Color fundus image, 45° FOV, Davis DR grading:
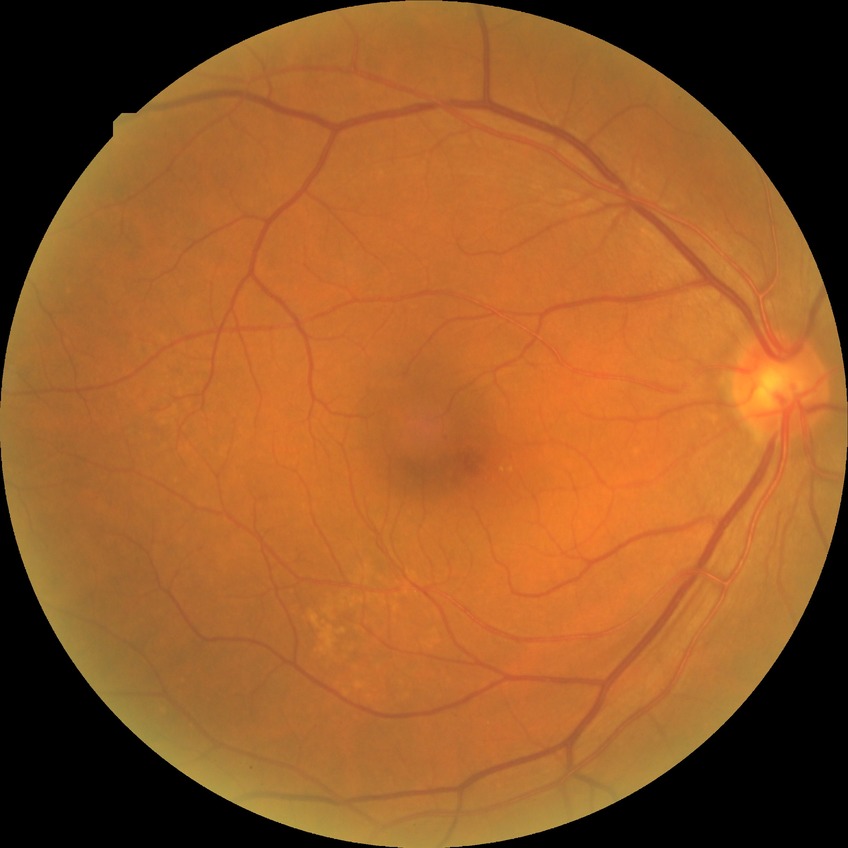 davis_grade: NDR (no diabetic retinopathy)